RetCam wide-field infant fundus image: 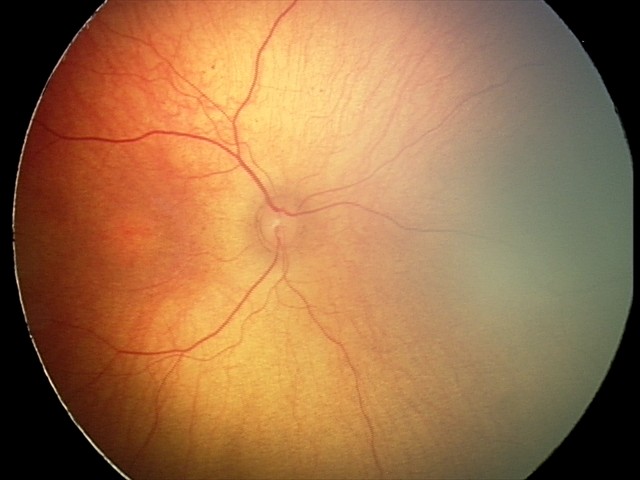

No retinal pathology identified on screening.